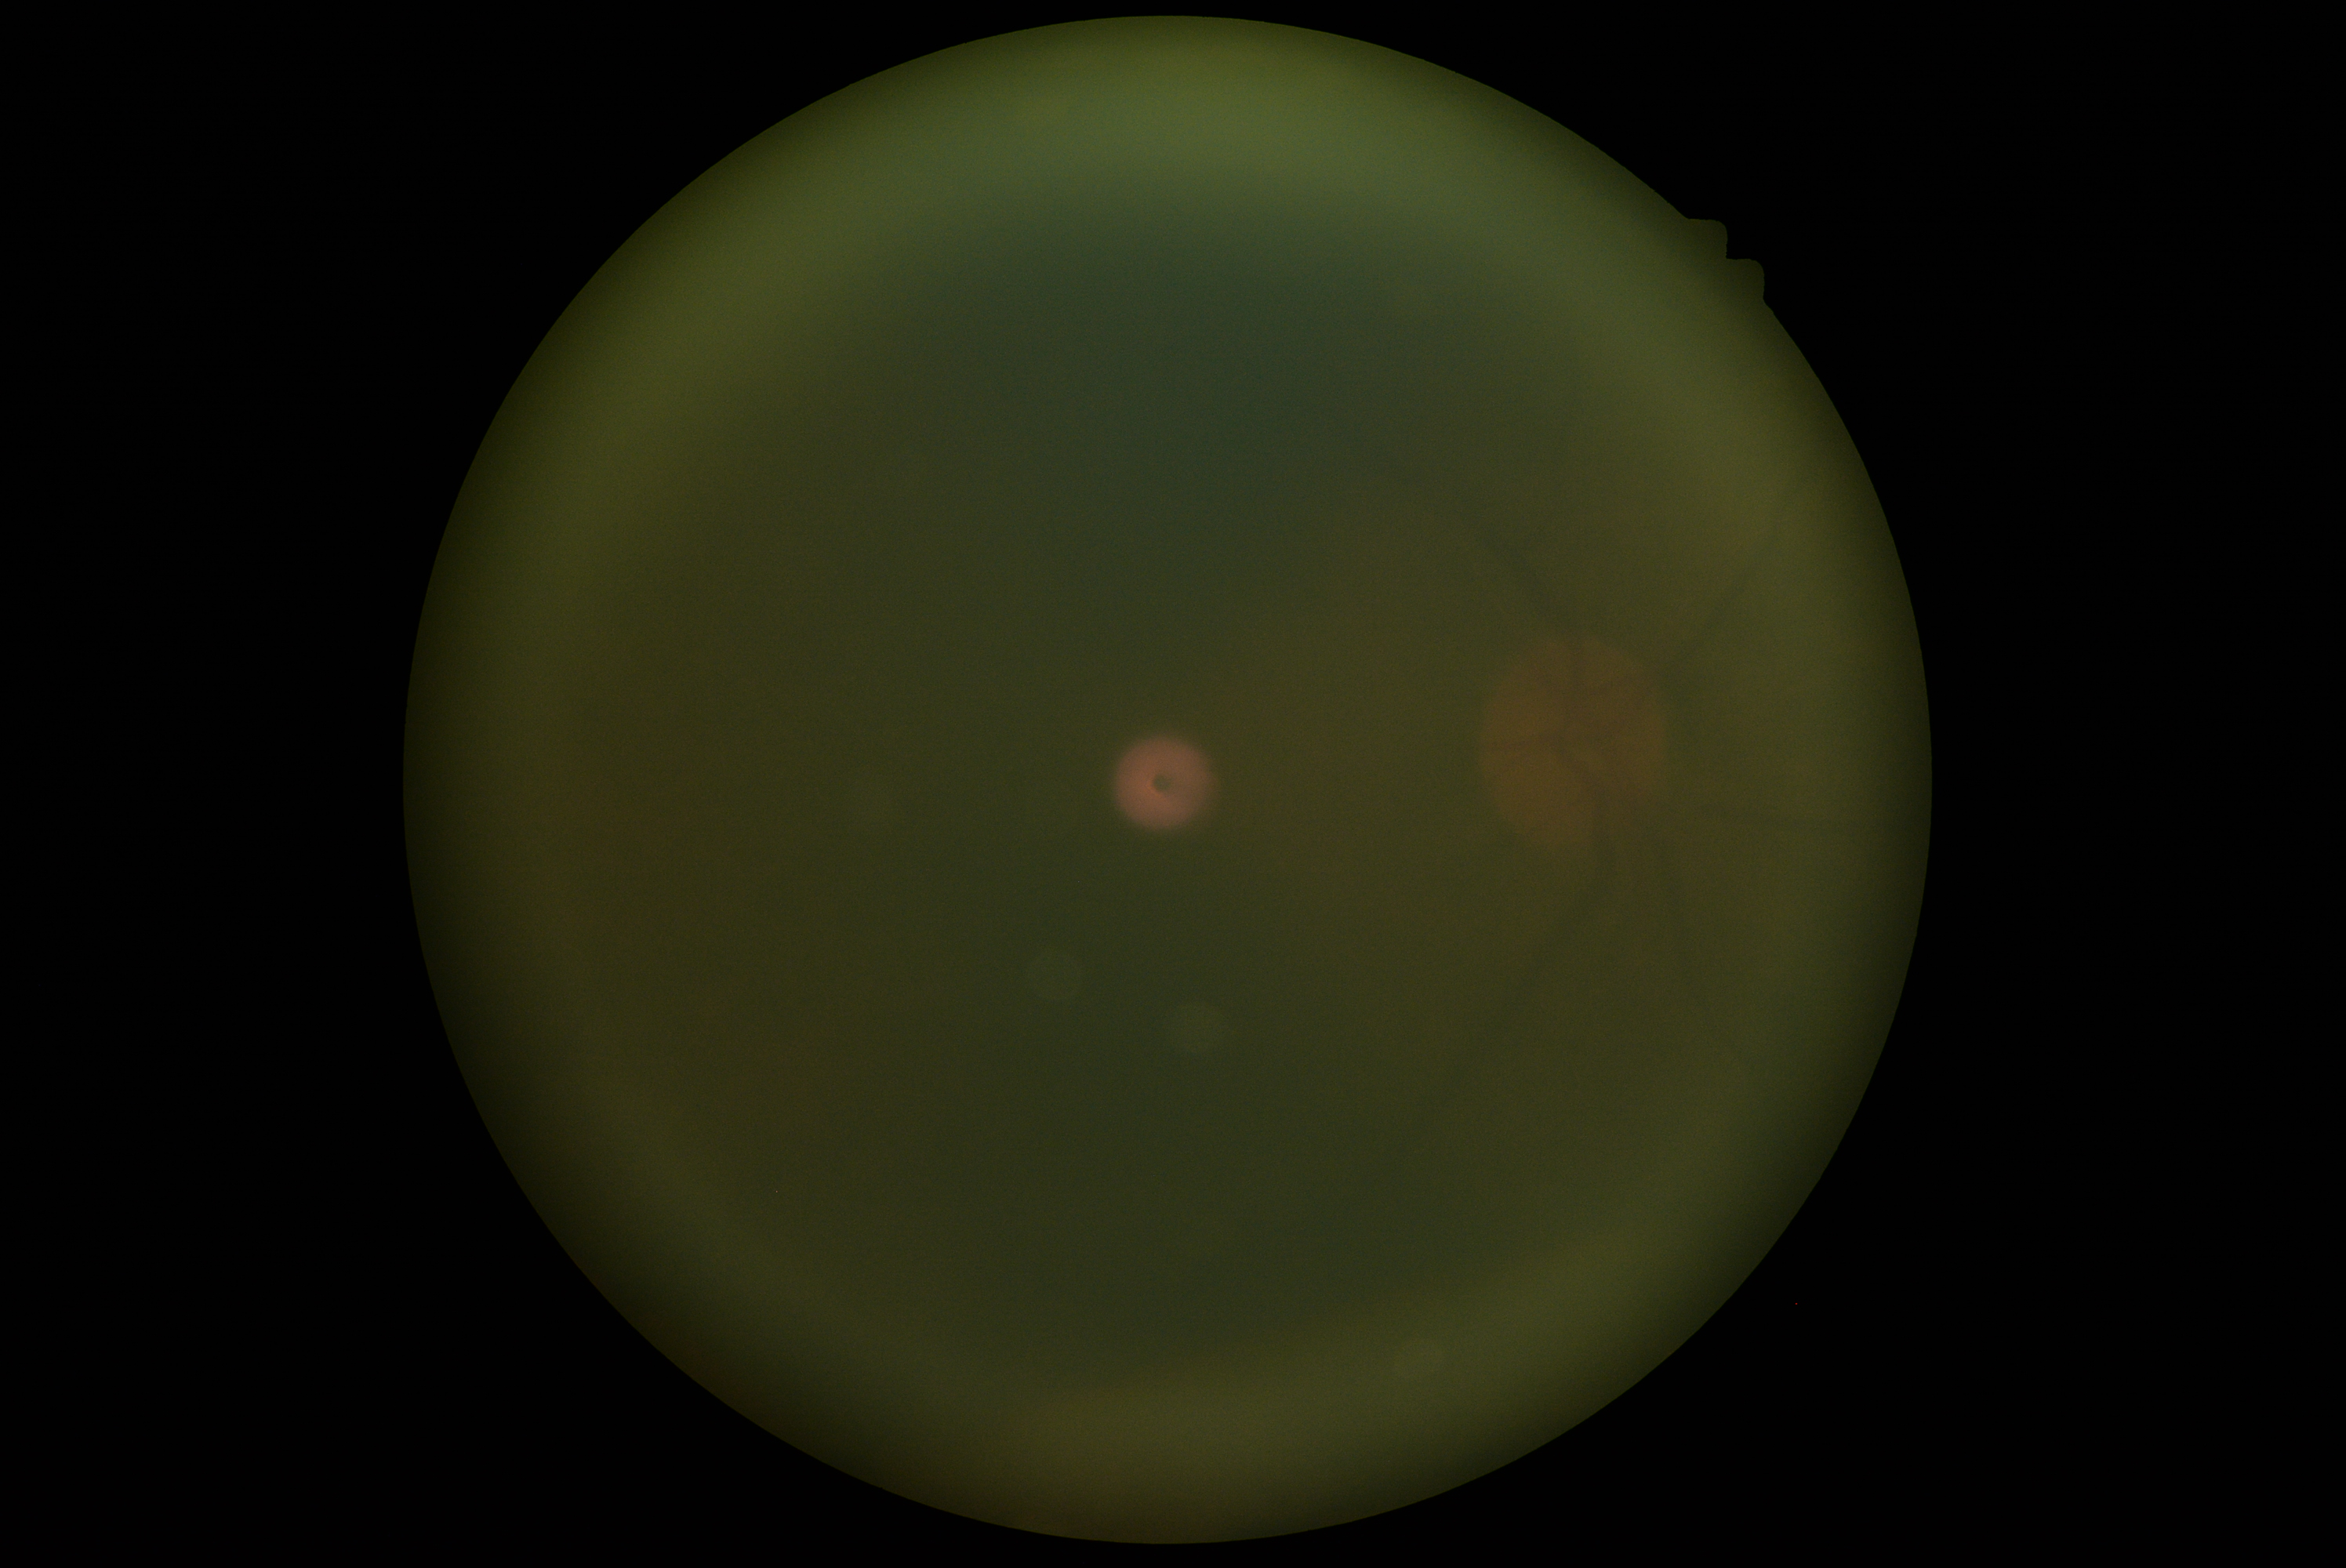 diabetic retinopathy grade: ungradable due to poor image quality